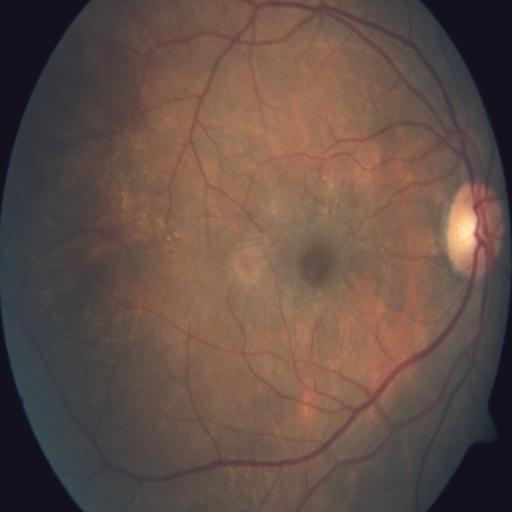

Findings:
- media haze